Nonmydriatic fundus photograph:
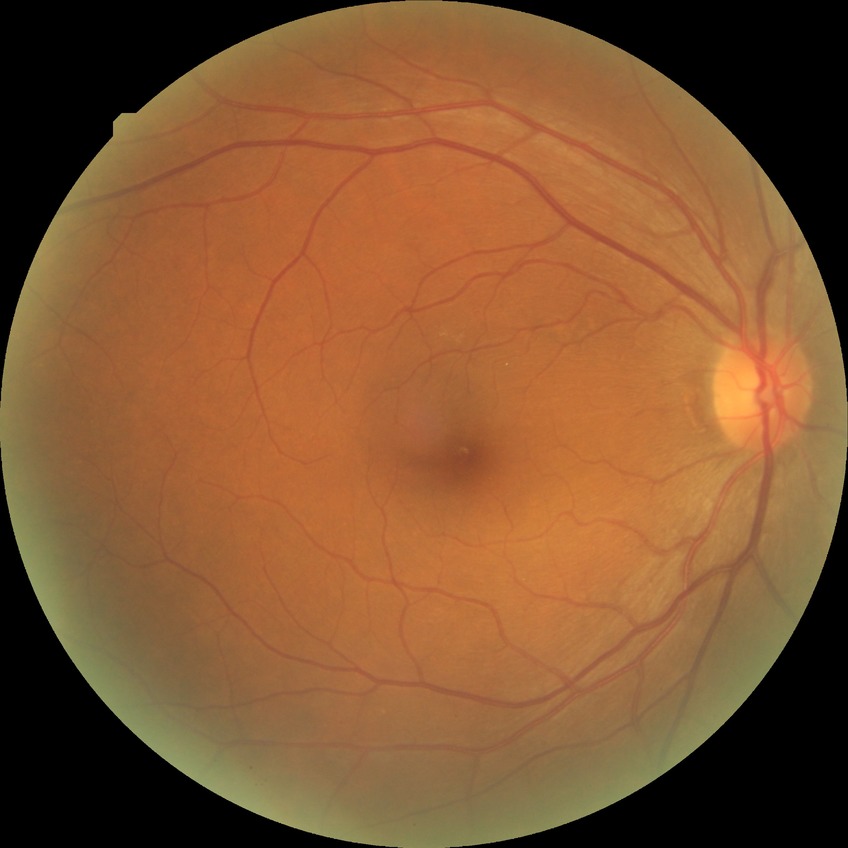

Diabetic retinopathy severity is no diabetic retinopathy.